No pharmacologic dilation. 848x848: 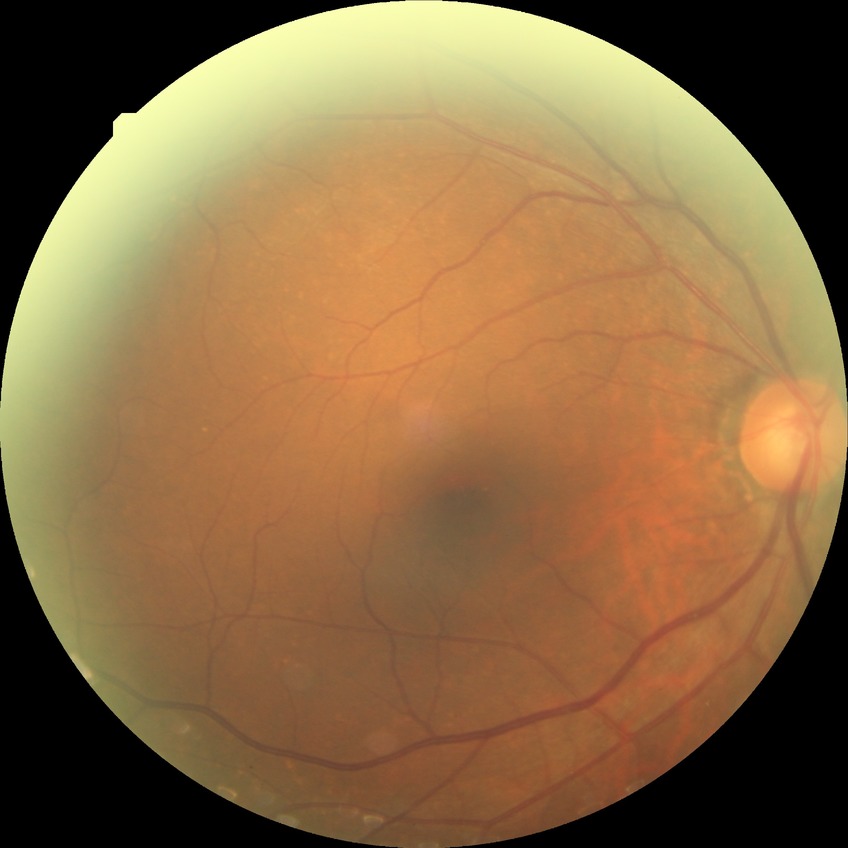
Diabetic retinopathy grade is no diabetic retinopathy.